Camera: NIDEK AFC-230
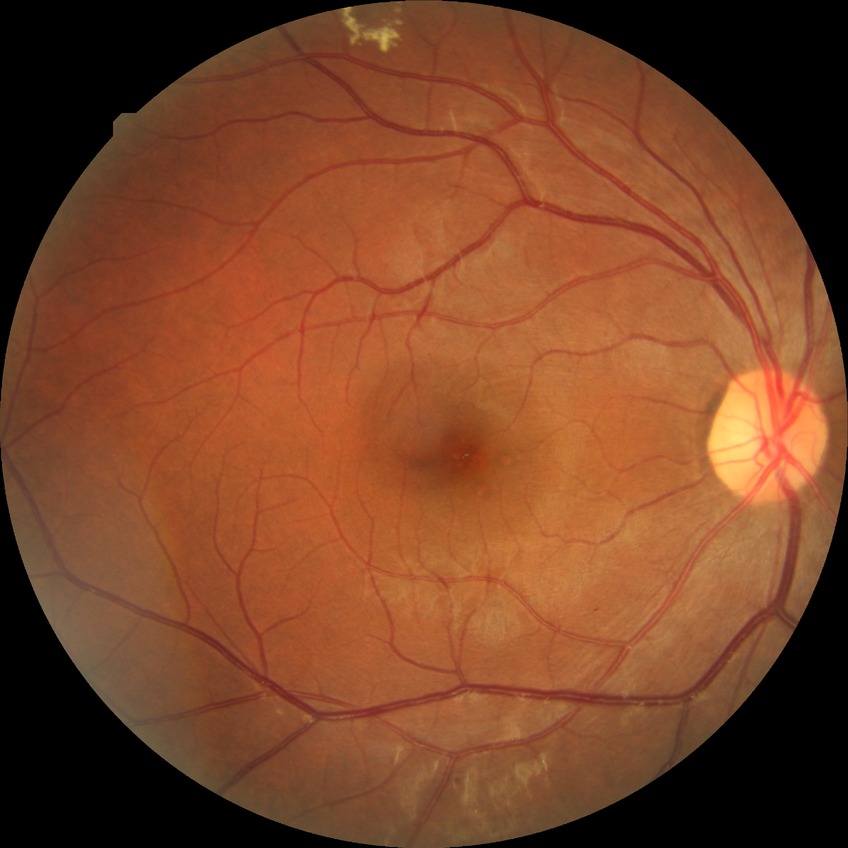 DR: SDR.